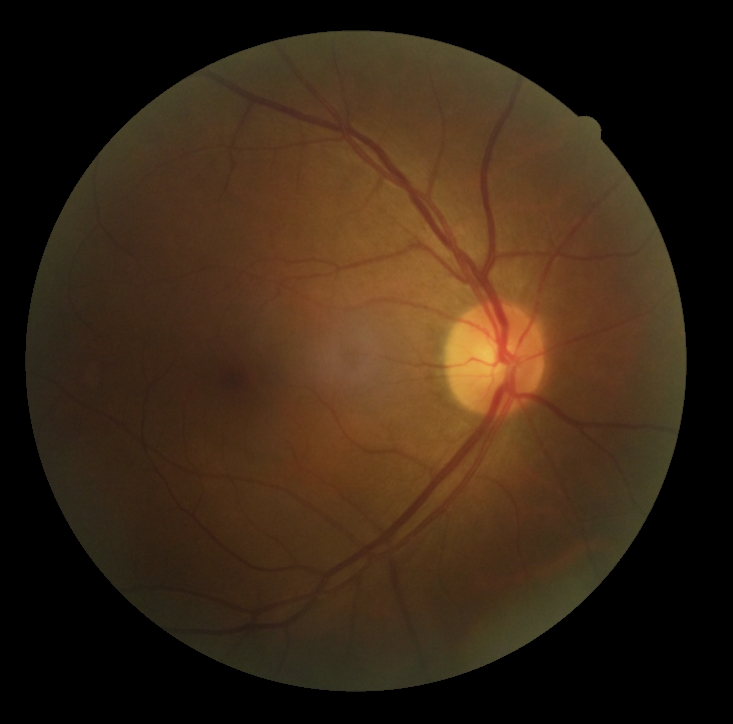 DR stage: grade 0 (no apparent retinopathy). No diabetic retinal disease findings.